Ultra-widefield fundus photograph.
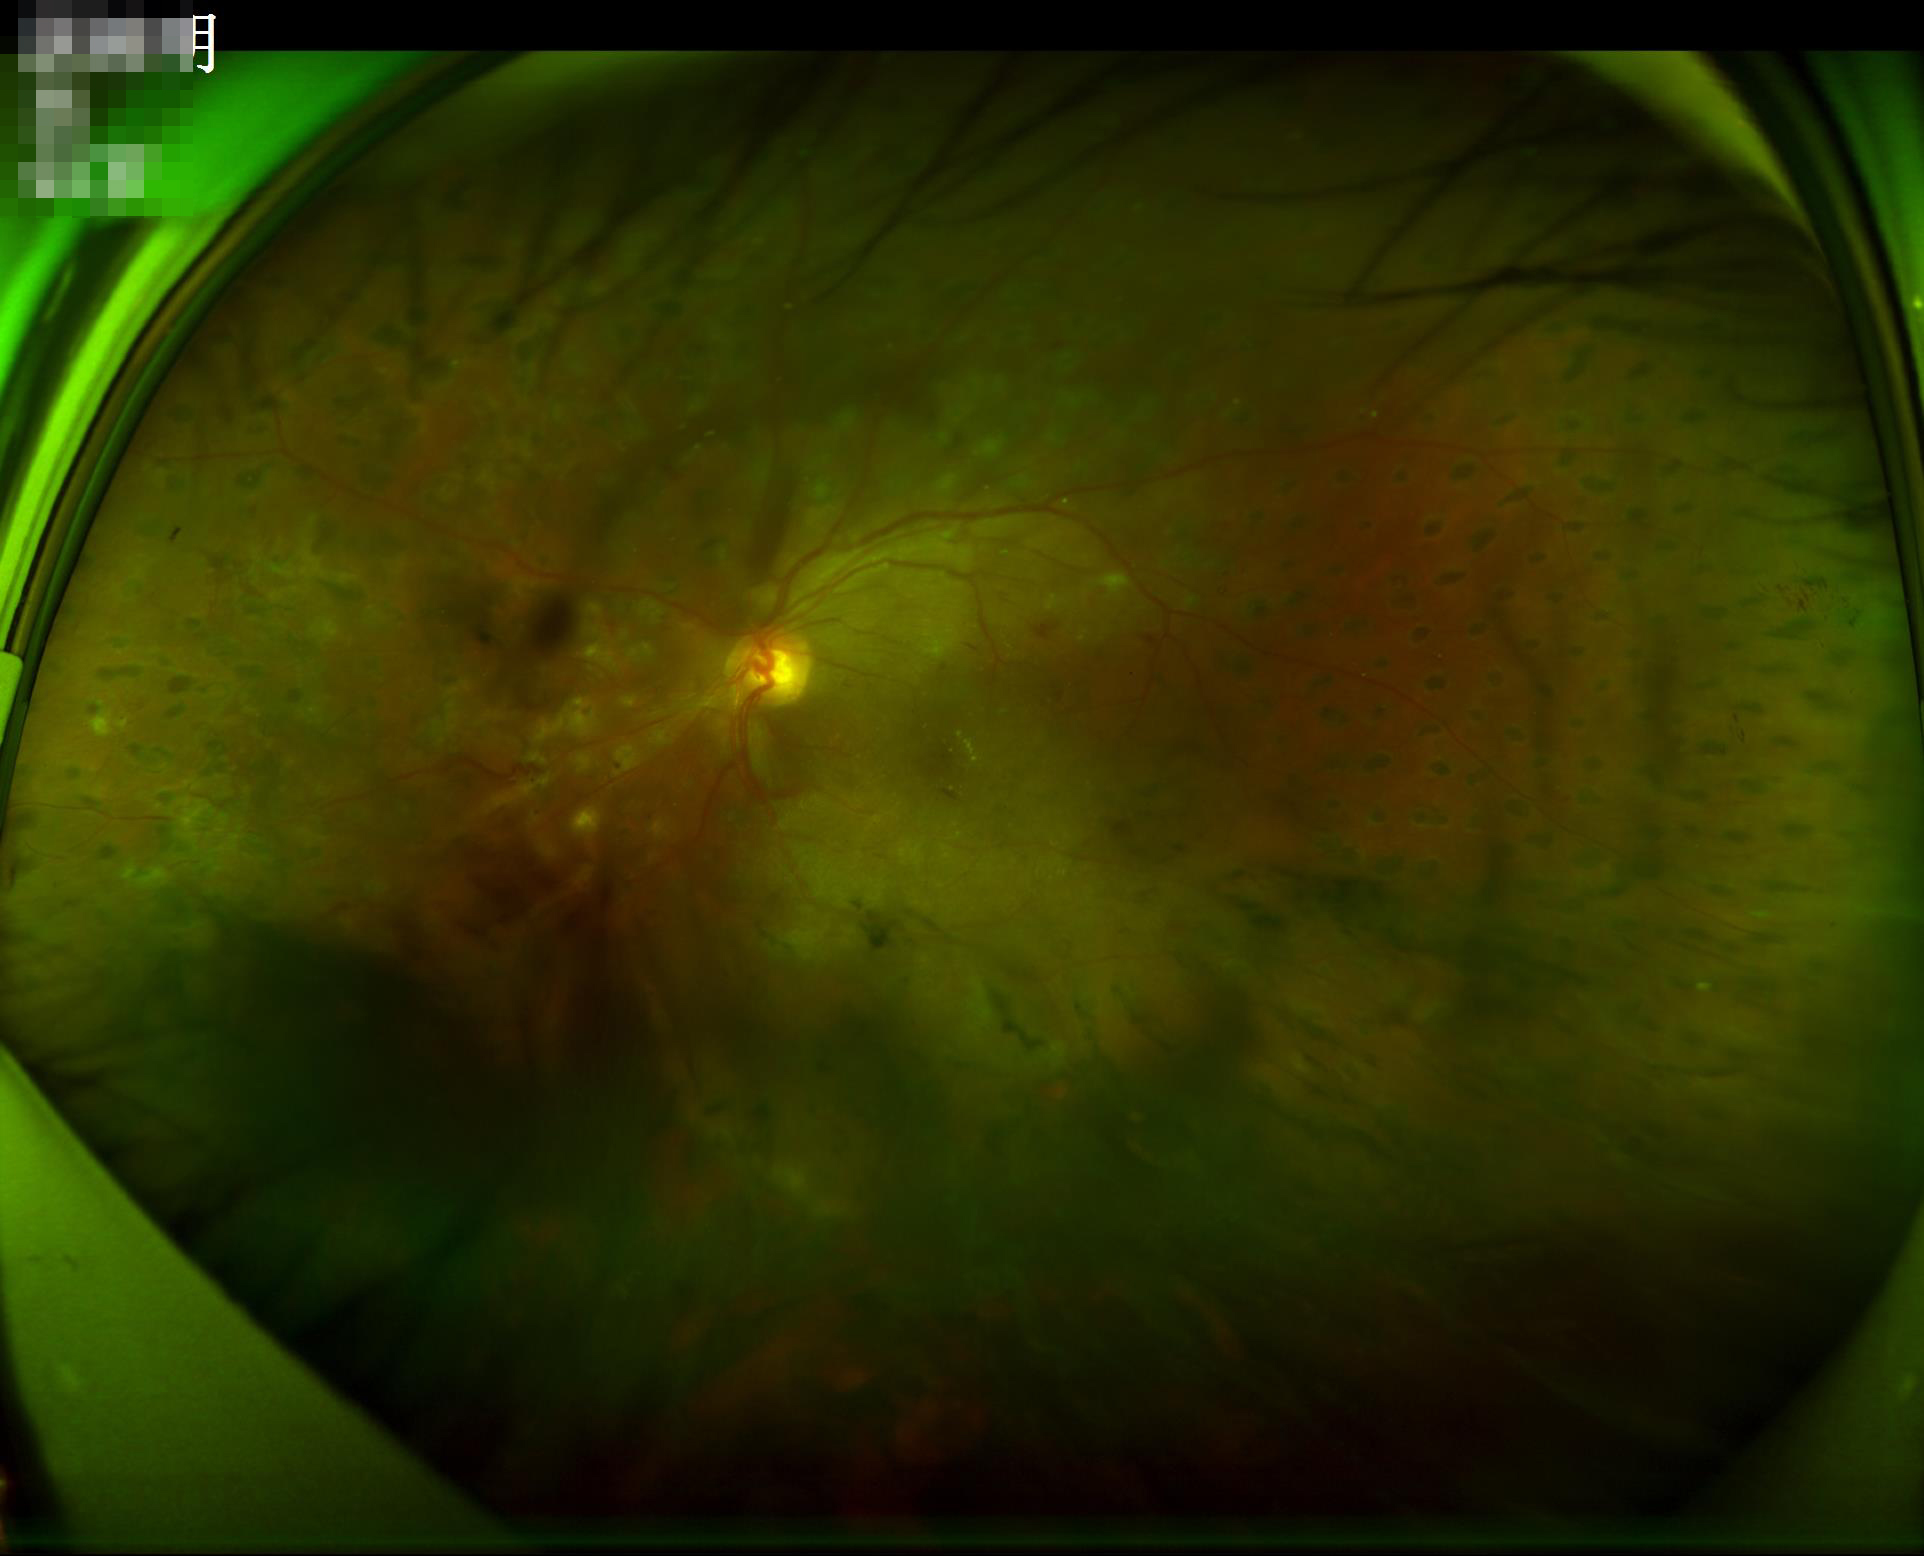 Image quality is suboptimal.
Illumination is uneven.
Out of focus; structures are indistinct.
Contrast is good.